Retinal fundus photograph:
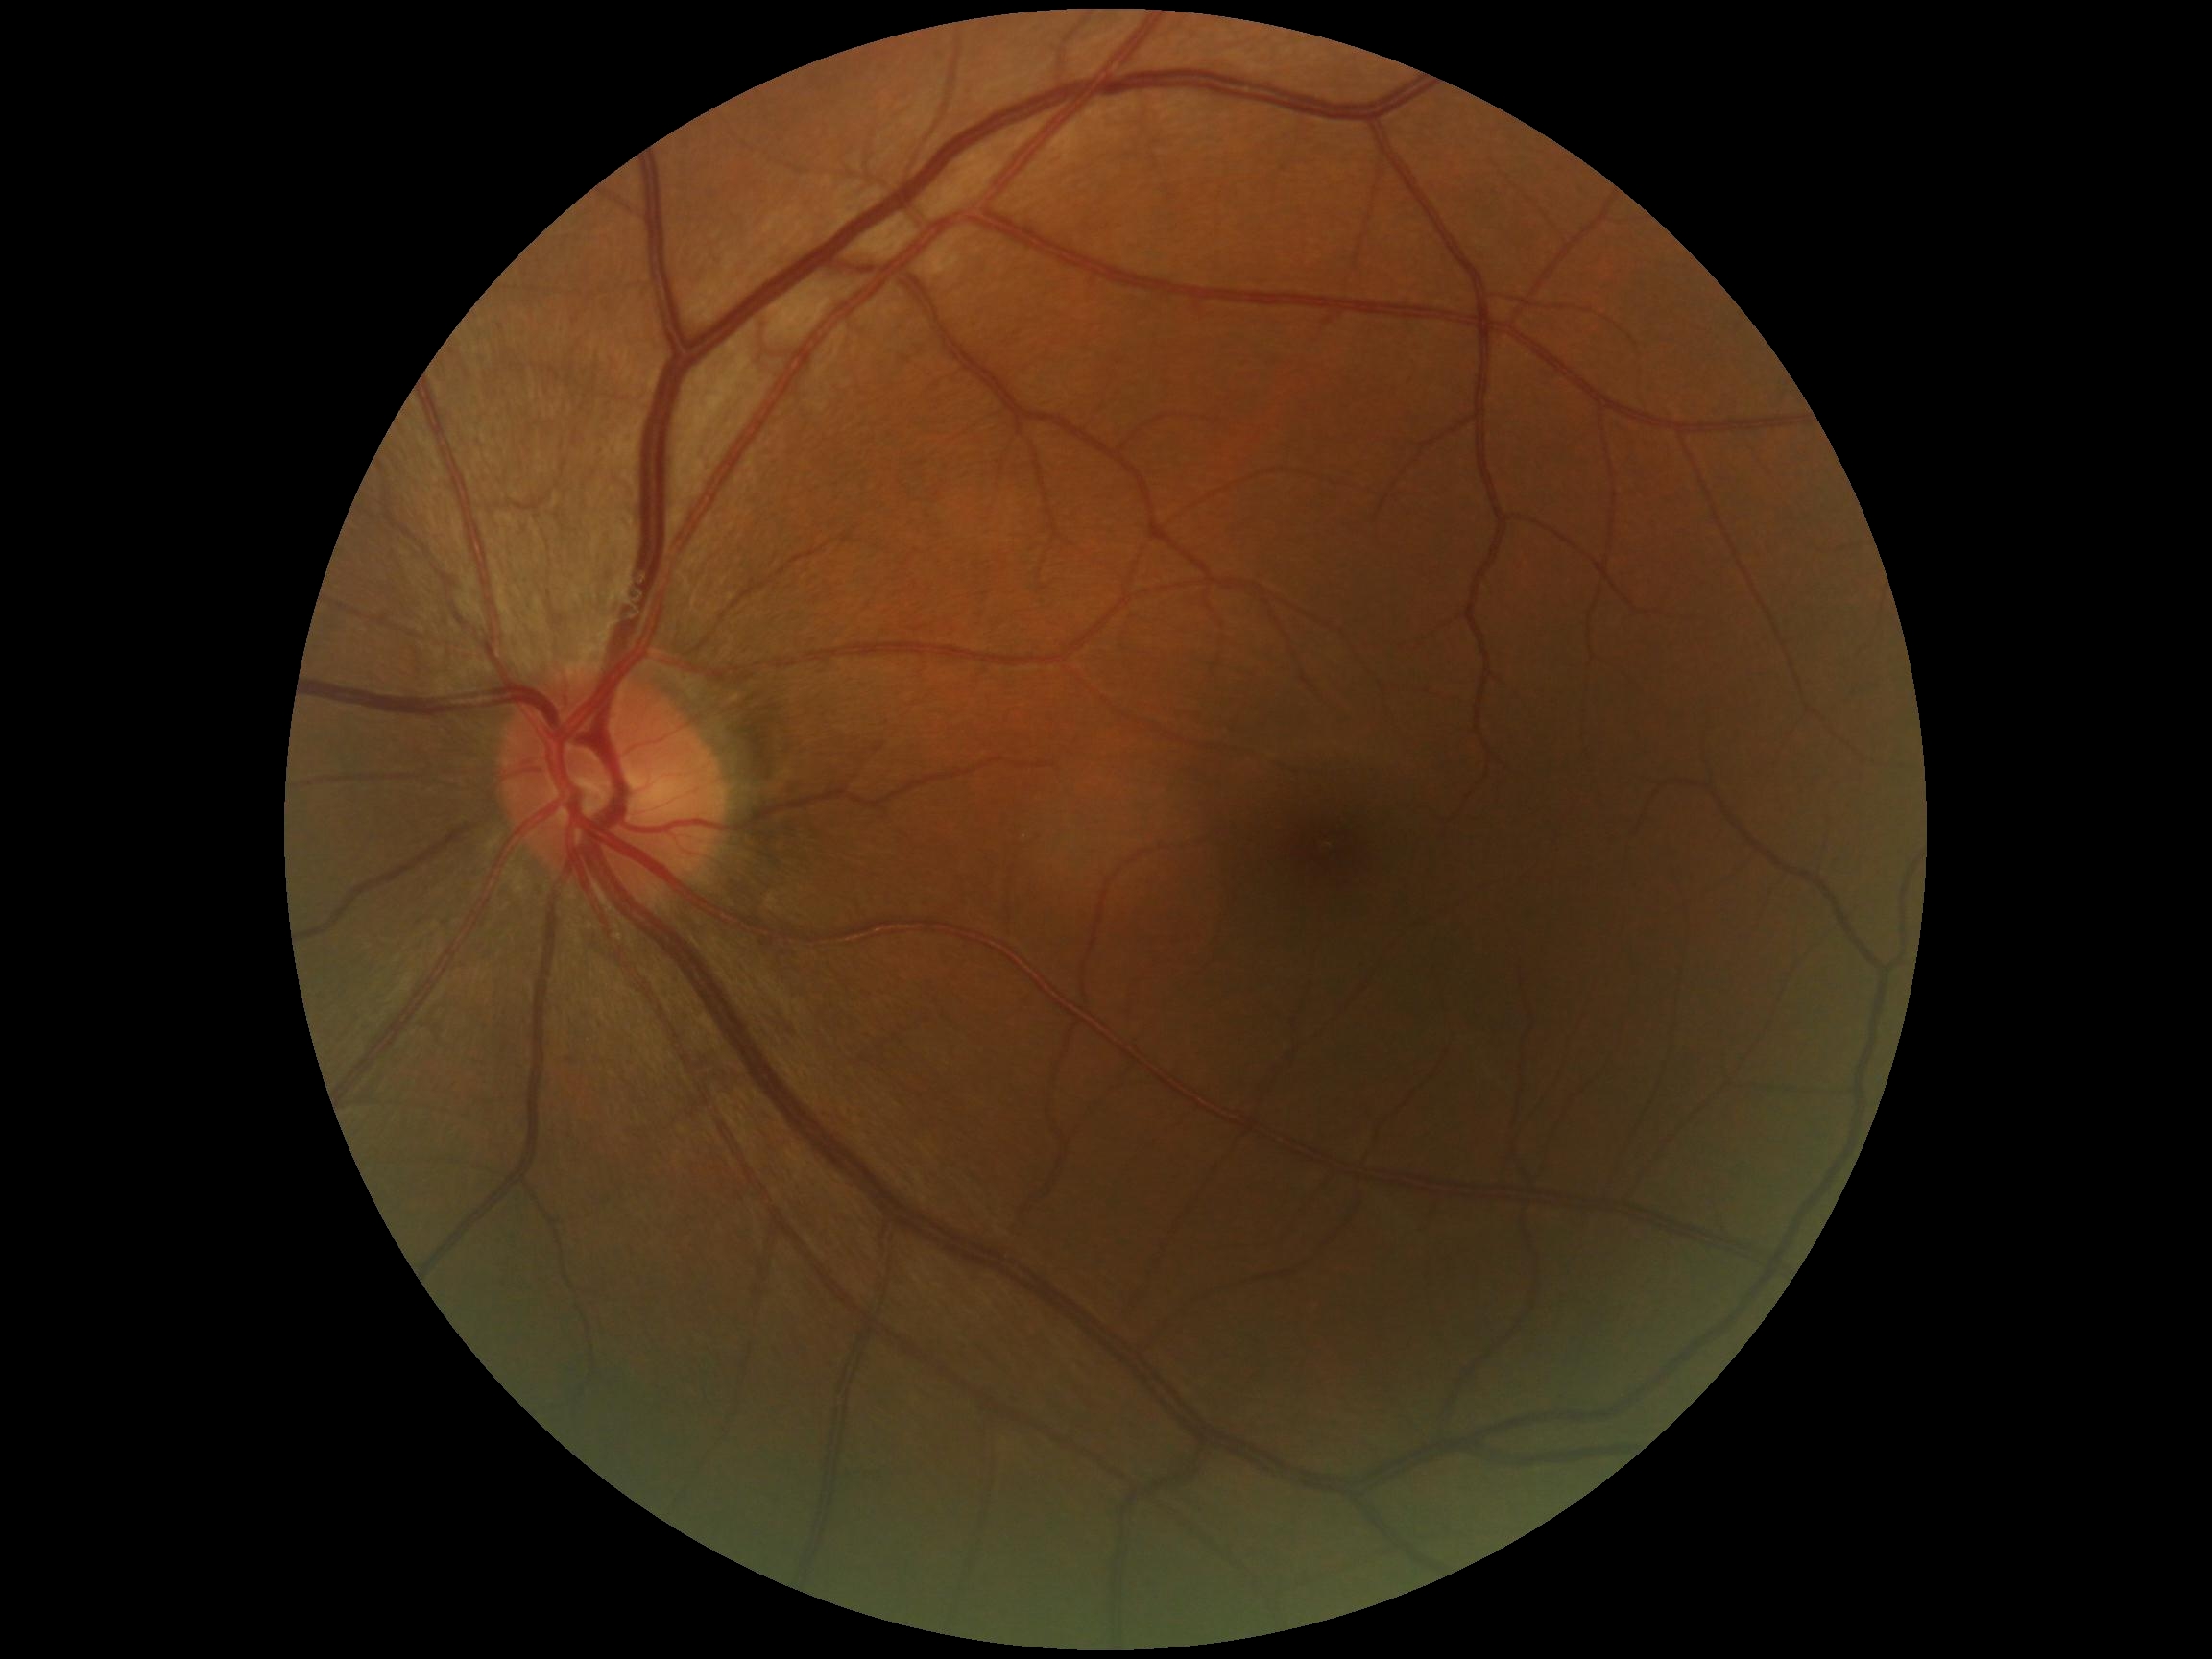

No DR findings. DR grade: 0 (no apparent retinopathy).